NIDEK AFC-230 · nonmydriatic
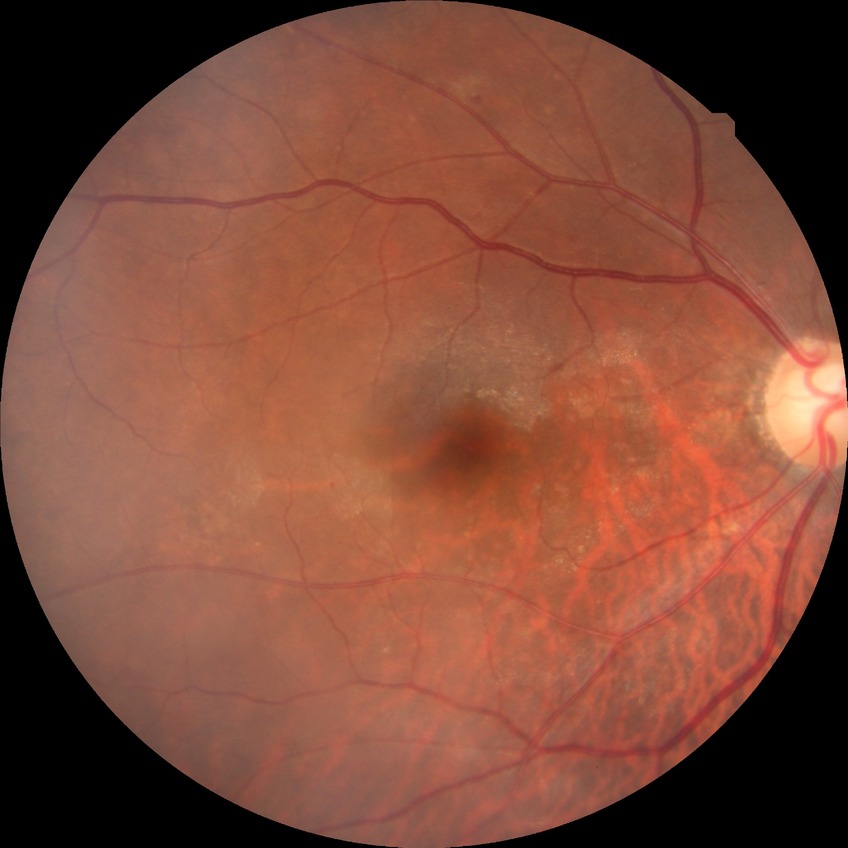 Davis DR grade is SDR.